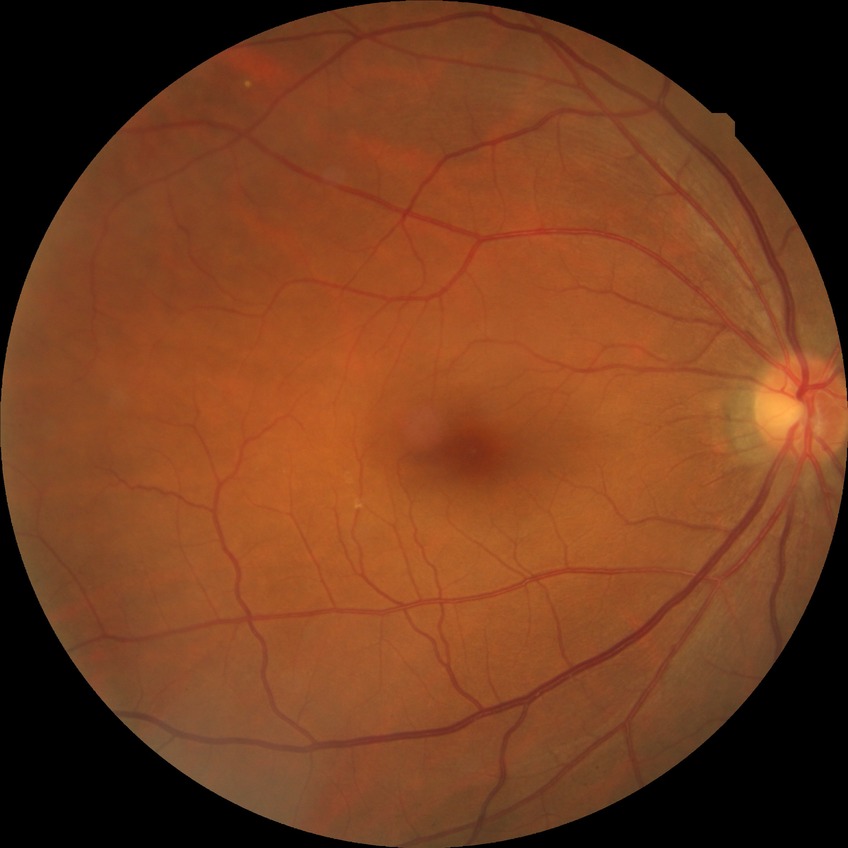

  dr_impression: no apparent DR
  davis_grade: NDR